Graded on the modified Davis scale · 848x848px
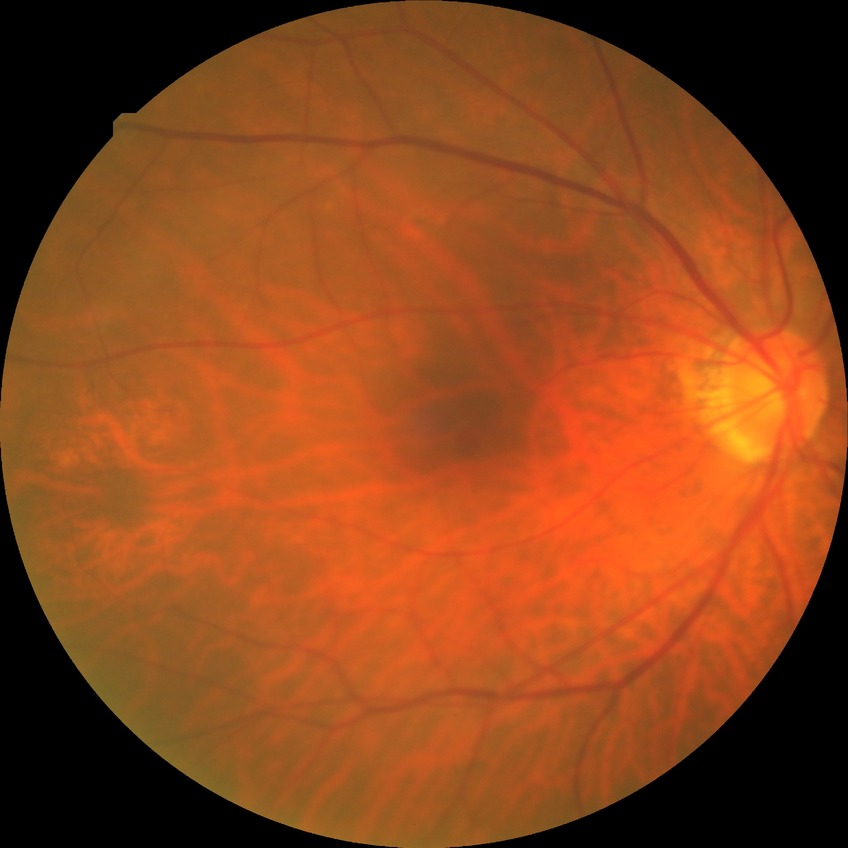

No diabetic retinal disease findings. Modified Davis grade is NDR.